Image size 1659x2212 — 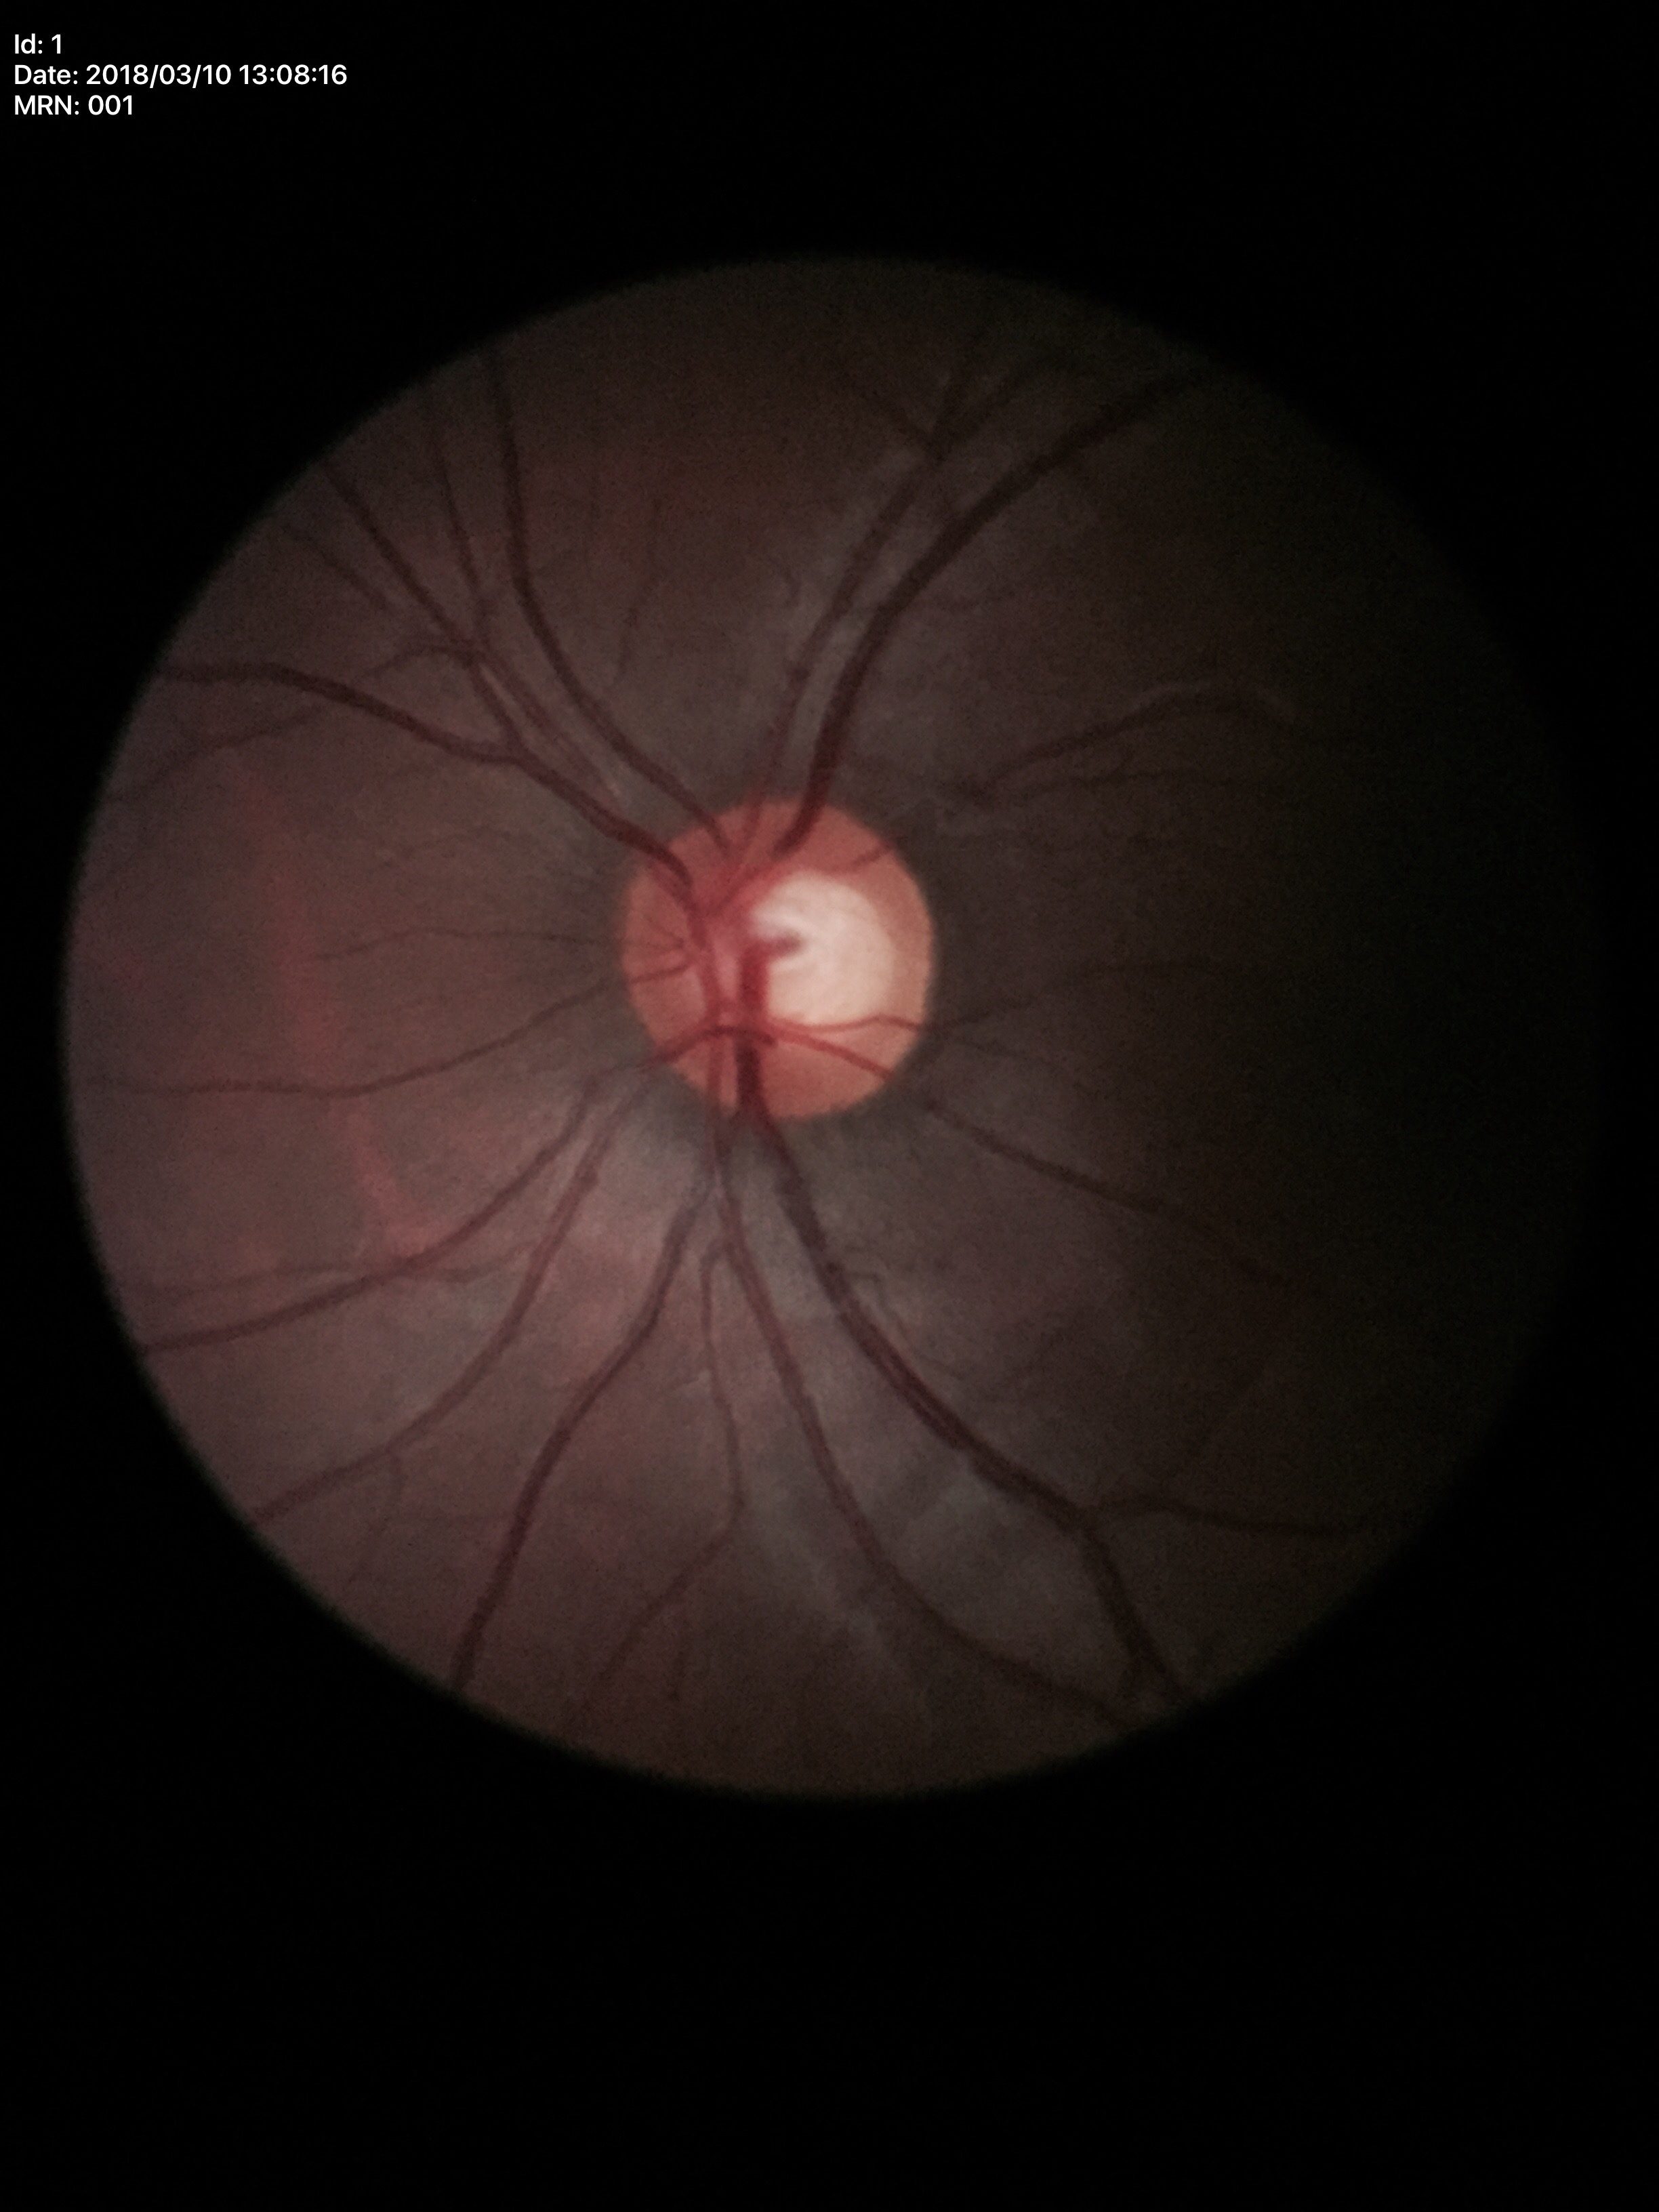
vertical cup-disc ratio (VCDR) = 0.57, Glaucoma assessment = no suspicious findings.